Infant wide-field retinal image · image size 640x480 — 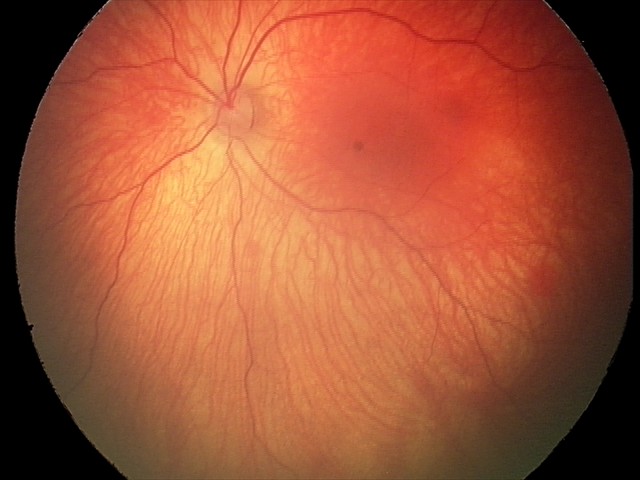
Diagnosis = retinal hemorrhages.